45° FOV, color fundus image, 2352 x 1568 pixels.
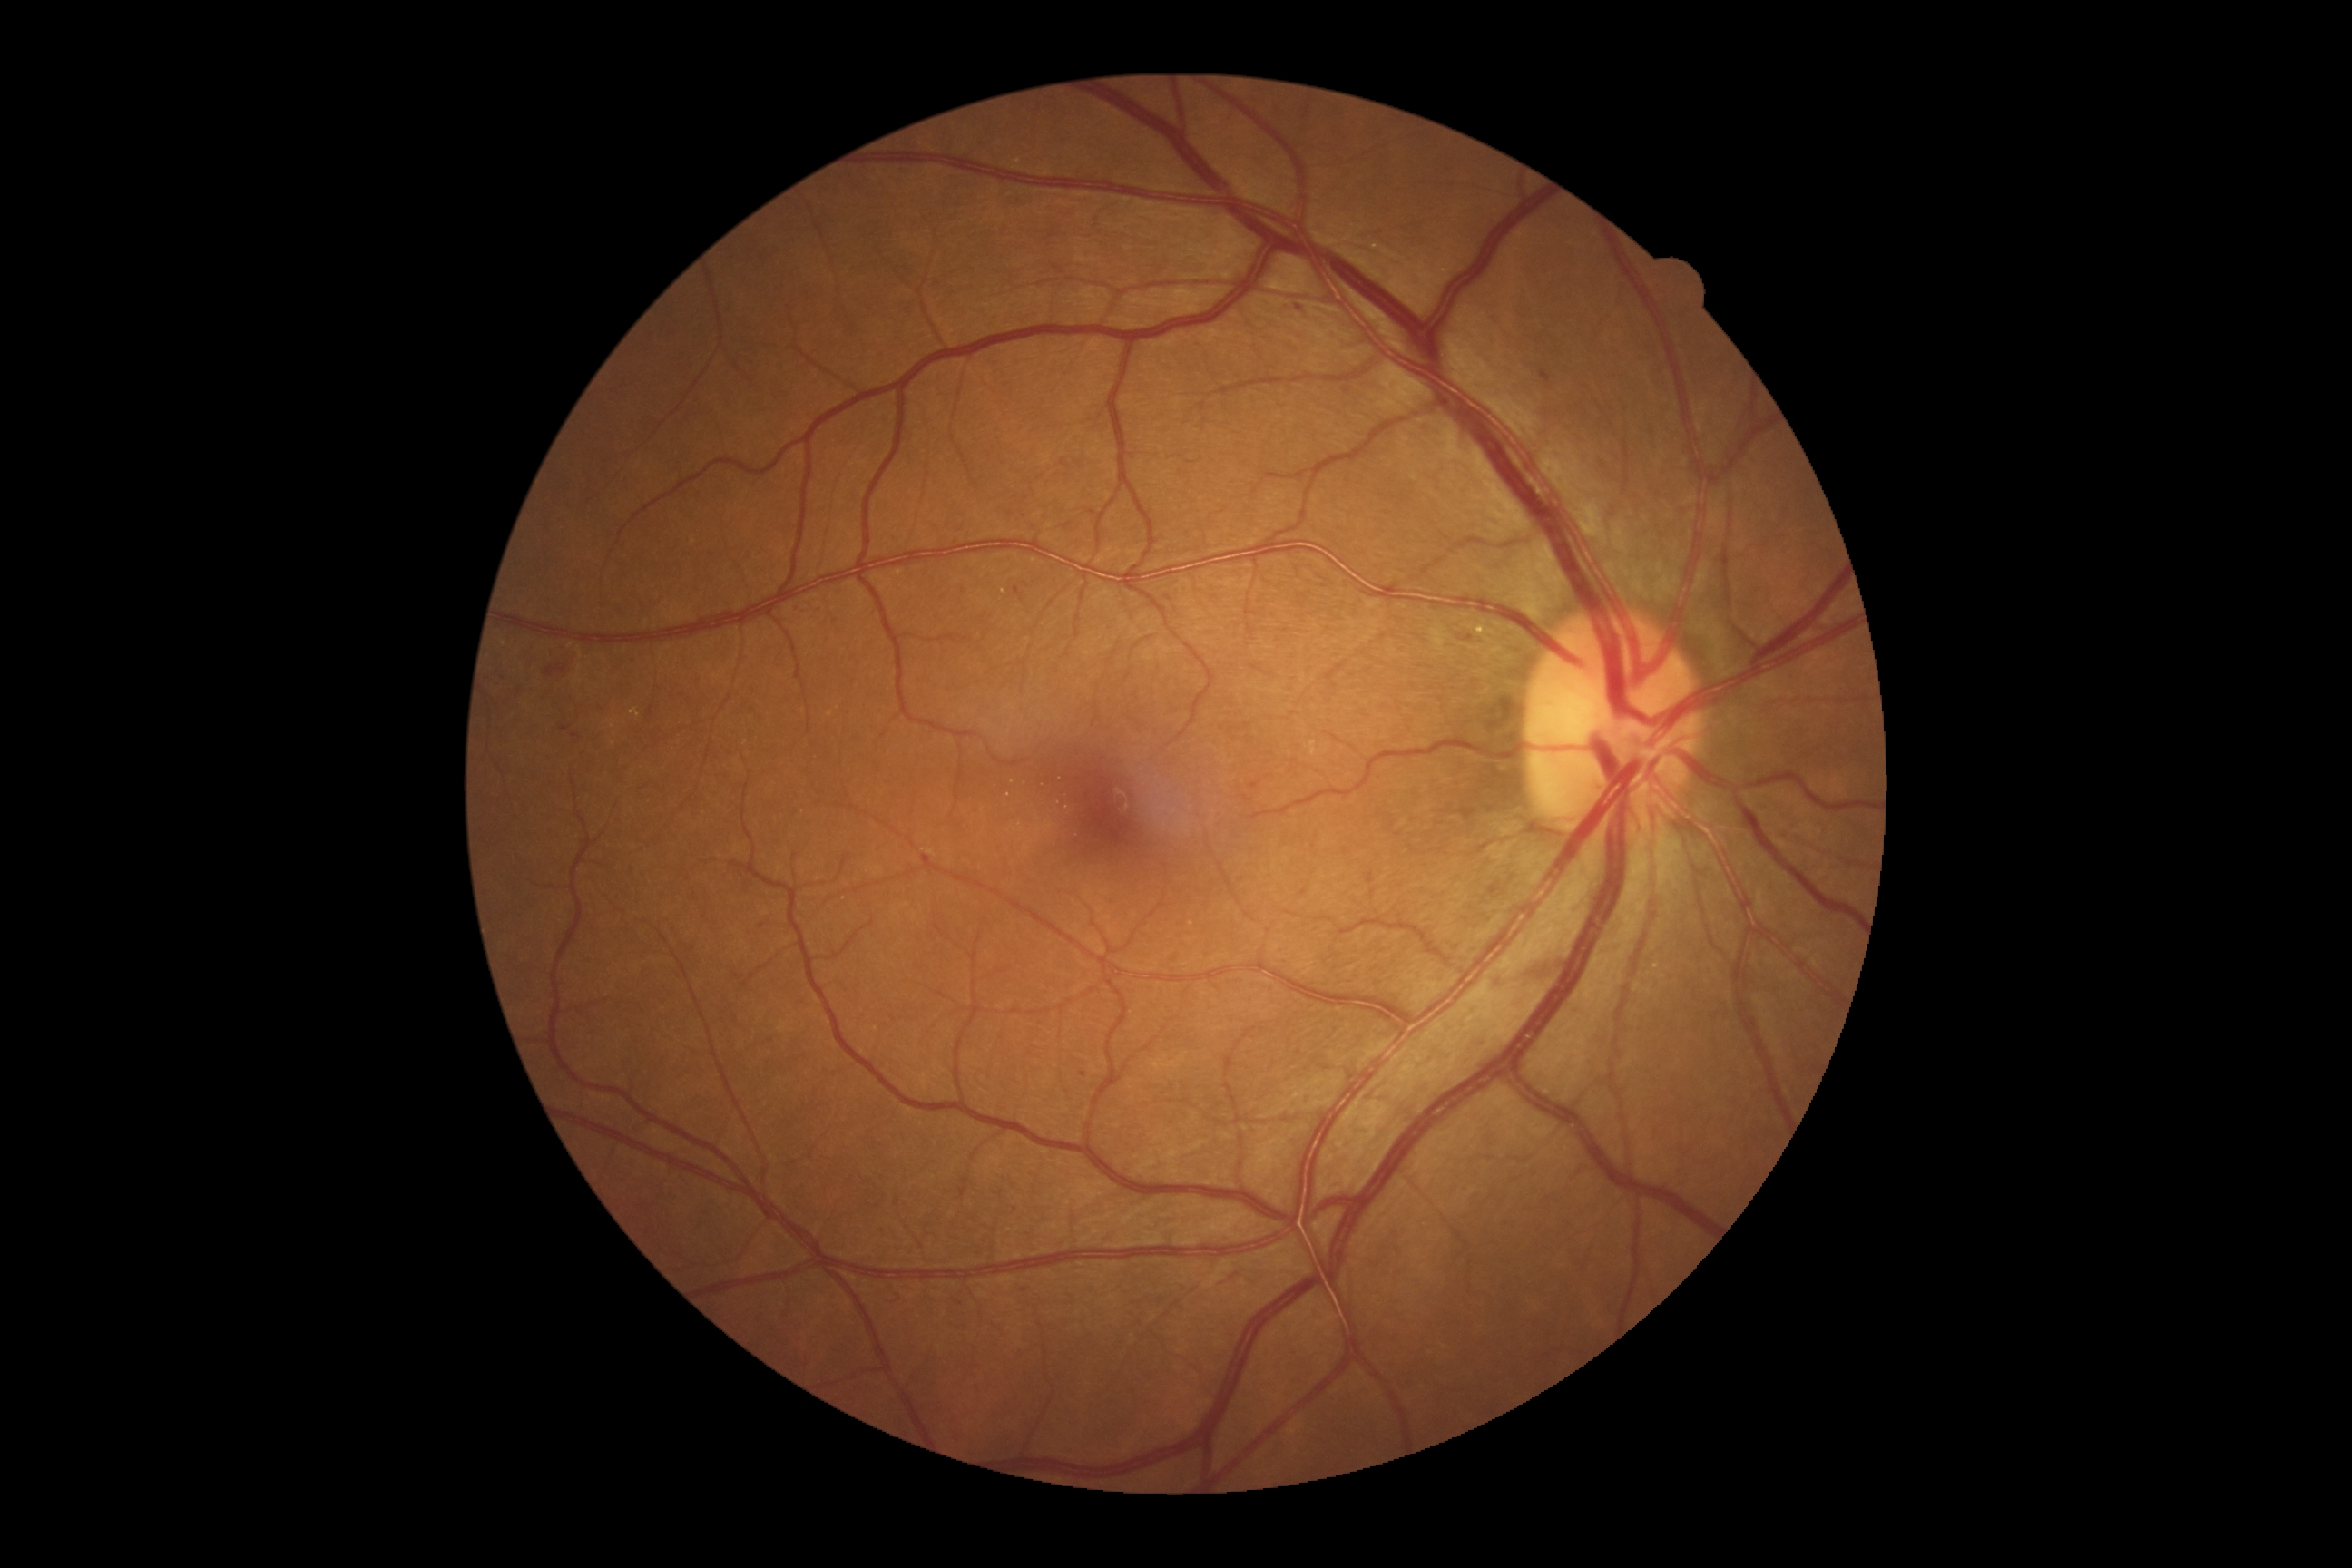
Retinopathy is 2.